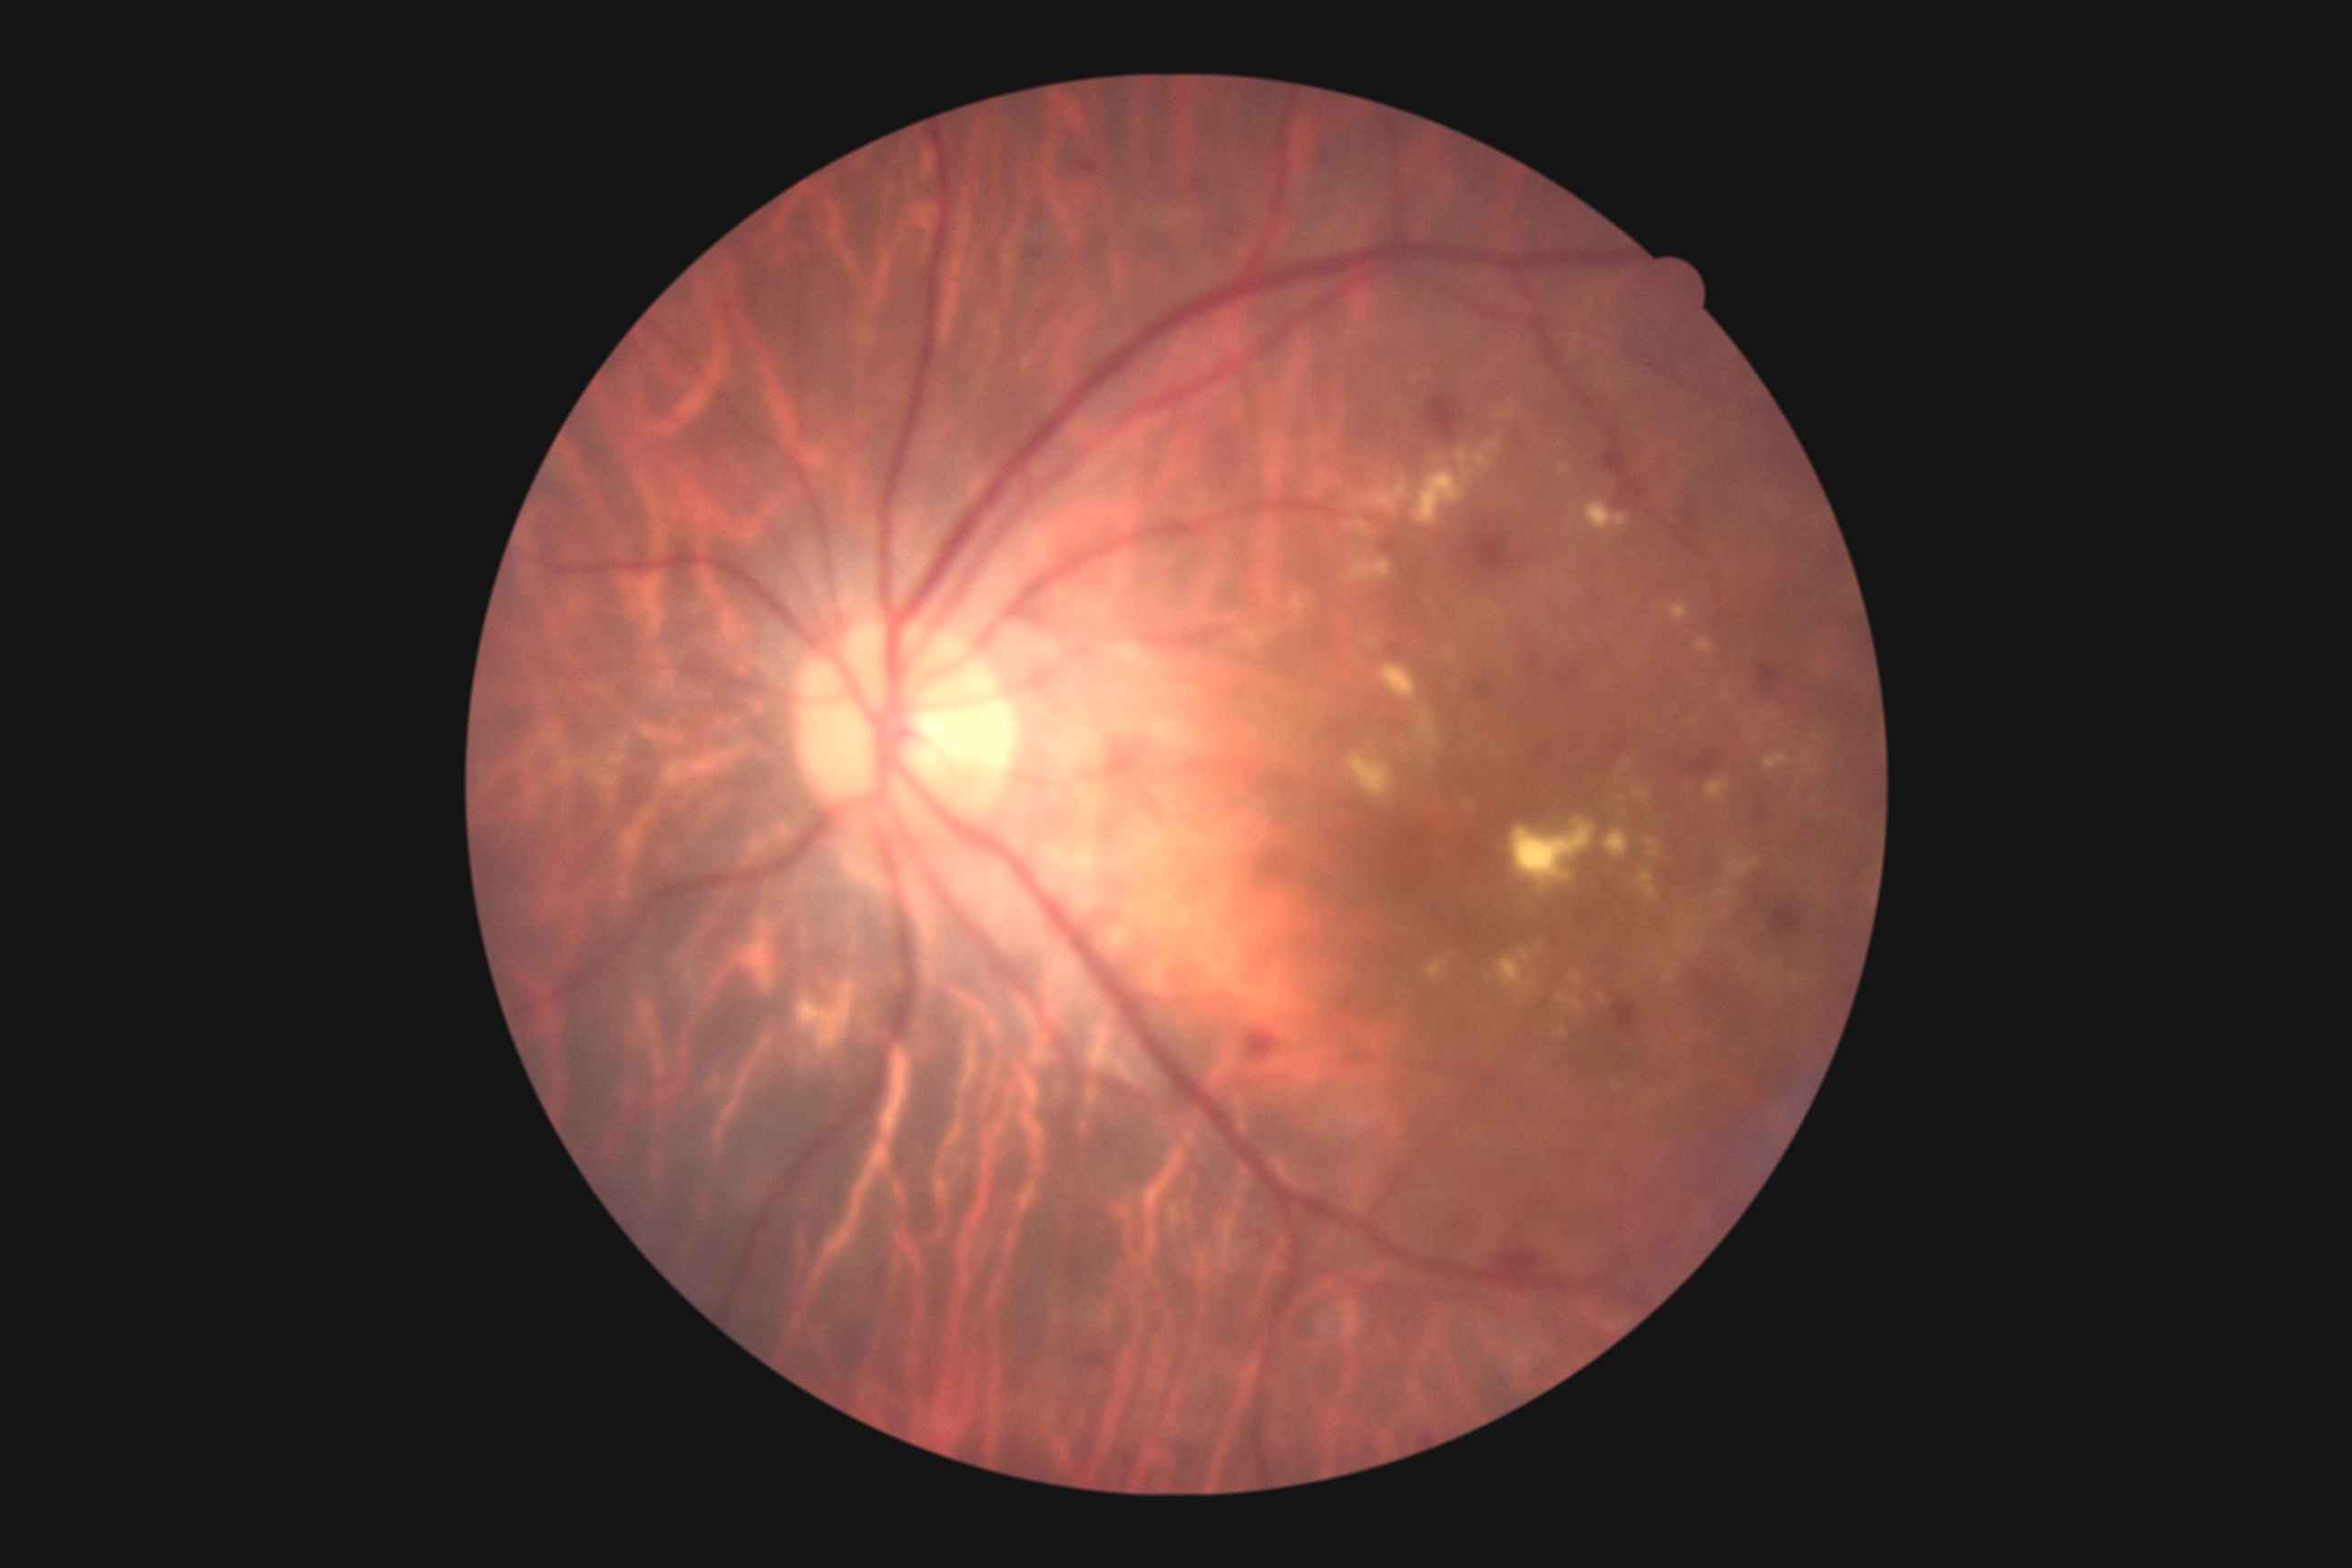

The retinopathy is classified as non-proliferative diabetic retinopathy. Diabetic retinopathy severity is 2/4.